Infant wide-field fundus photograph: 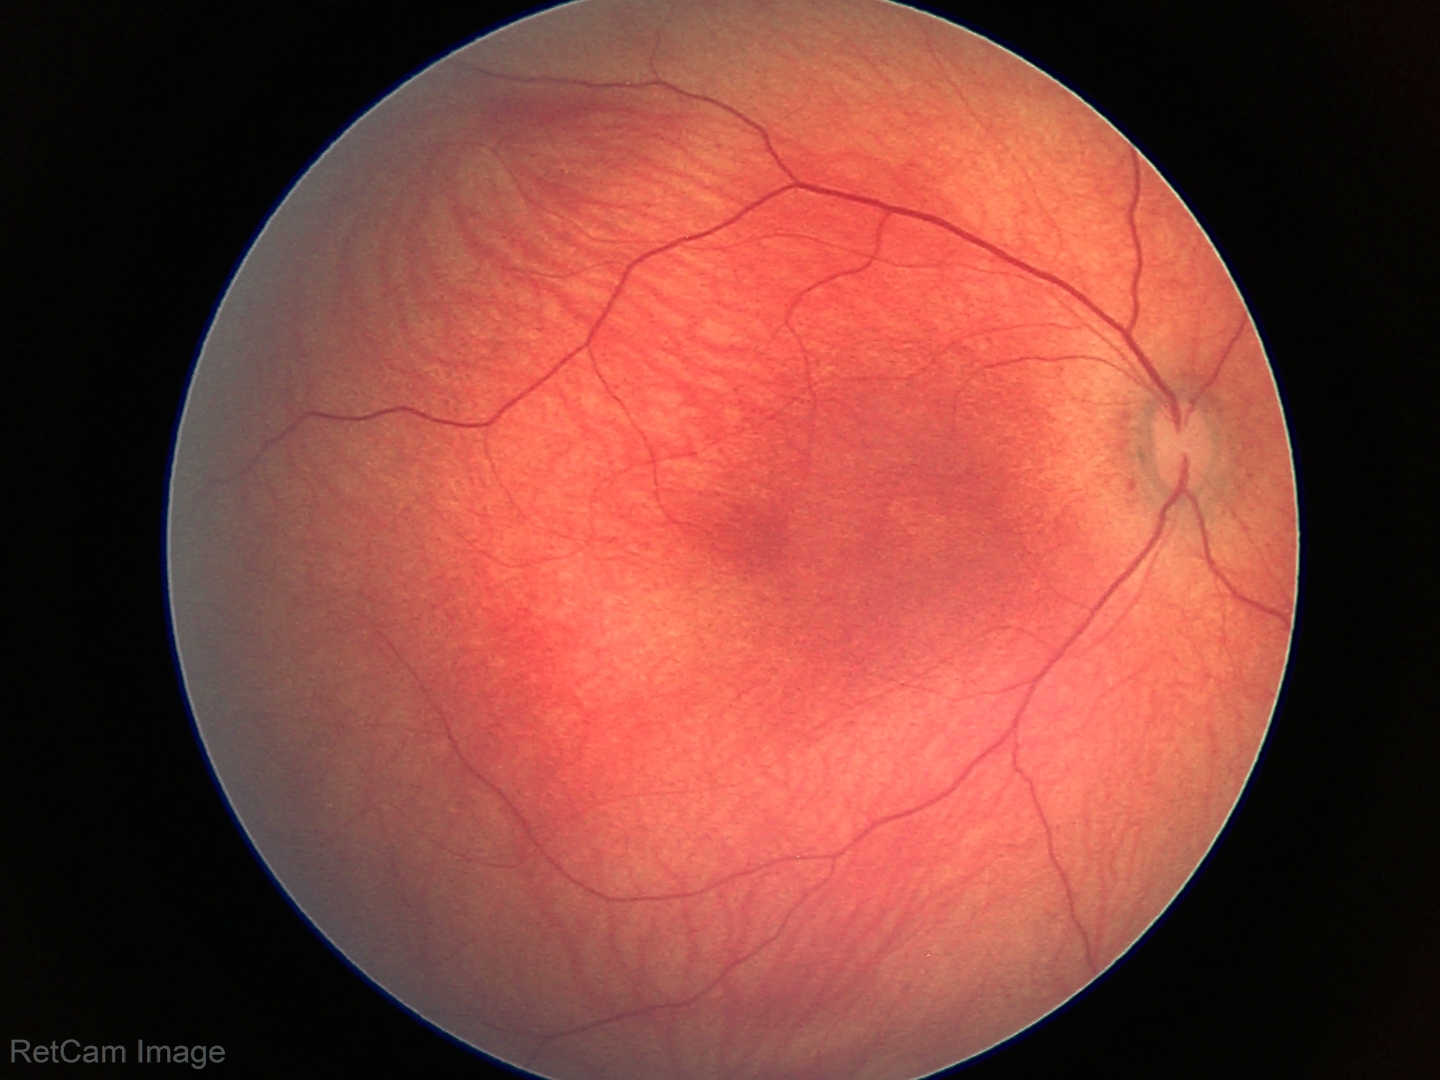 No retinal pathology identified on screening.